Color fundus photograph, 2212x1659 — 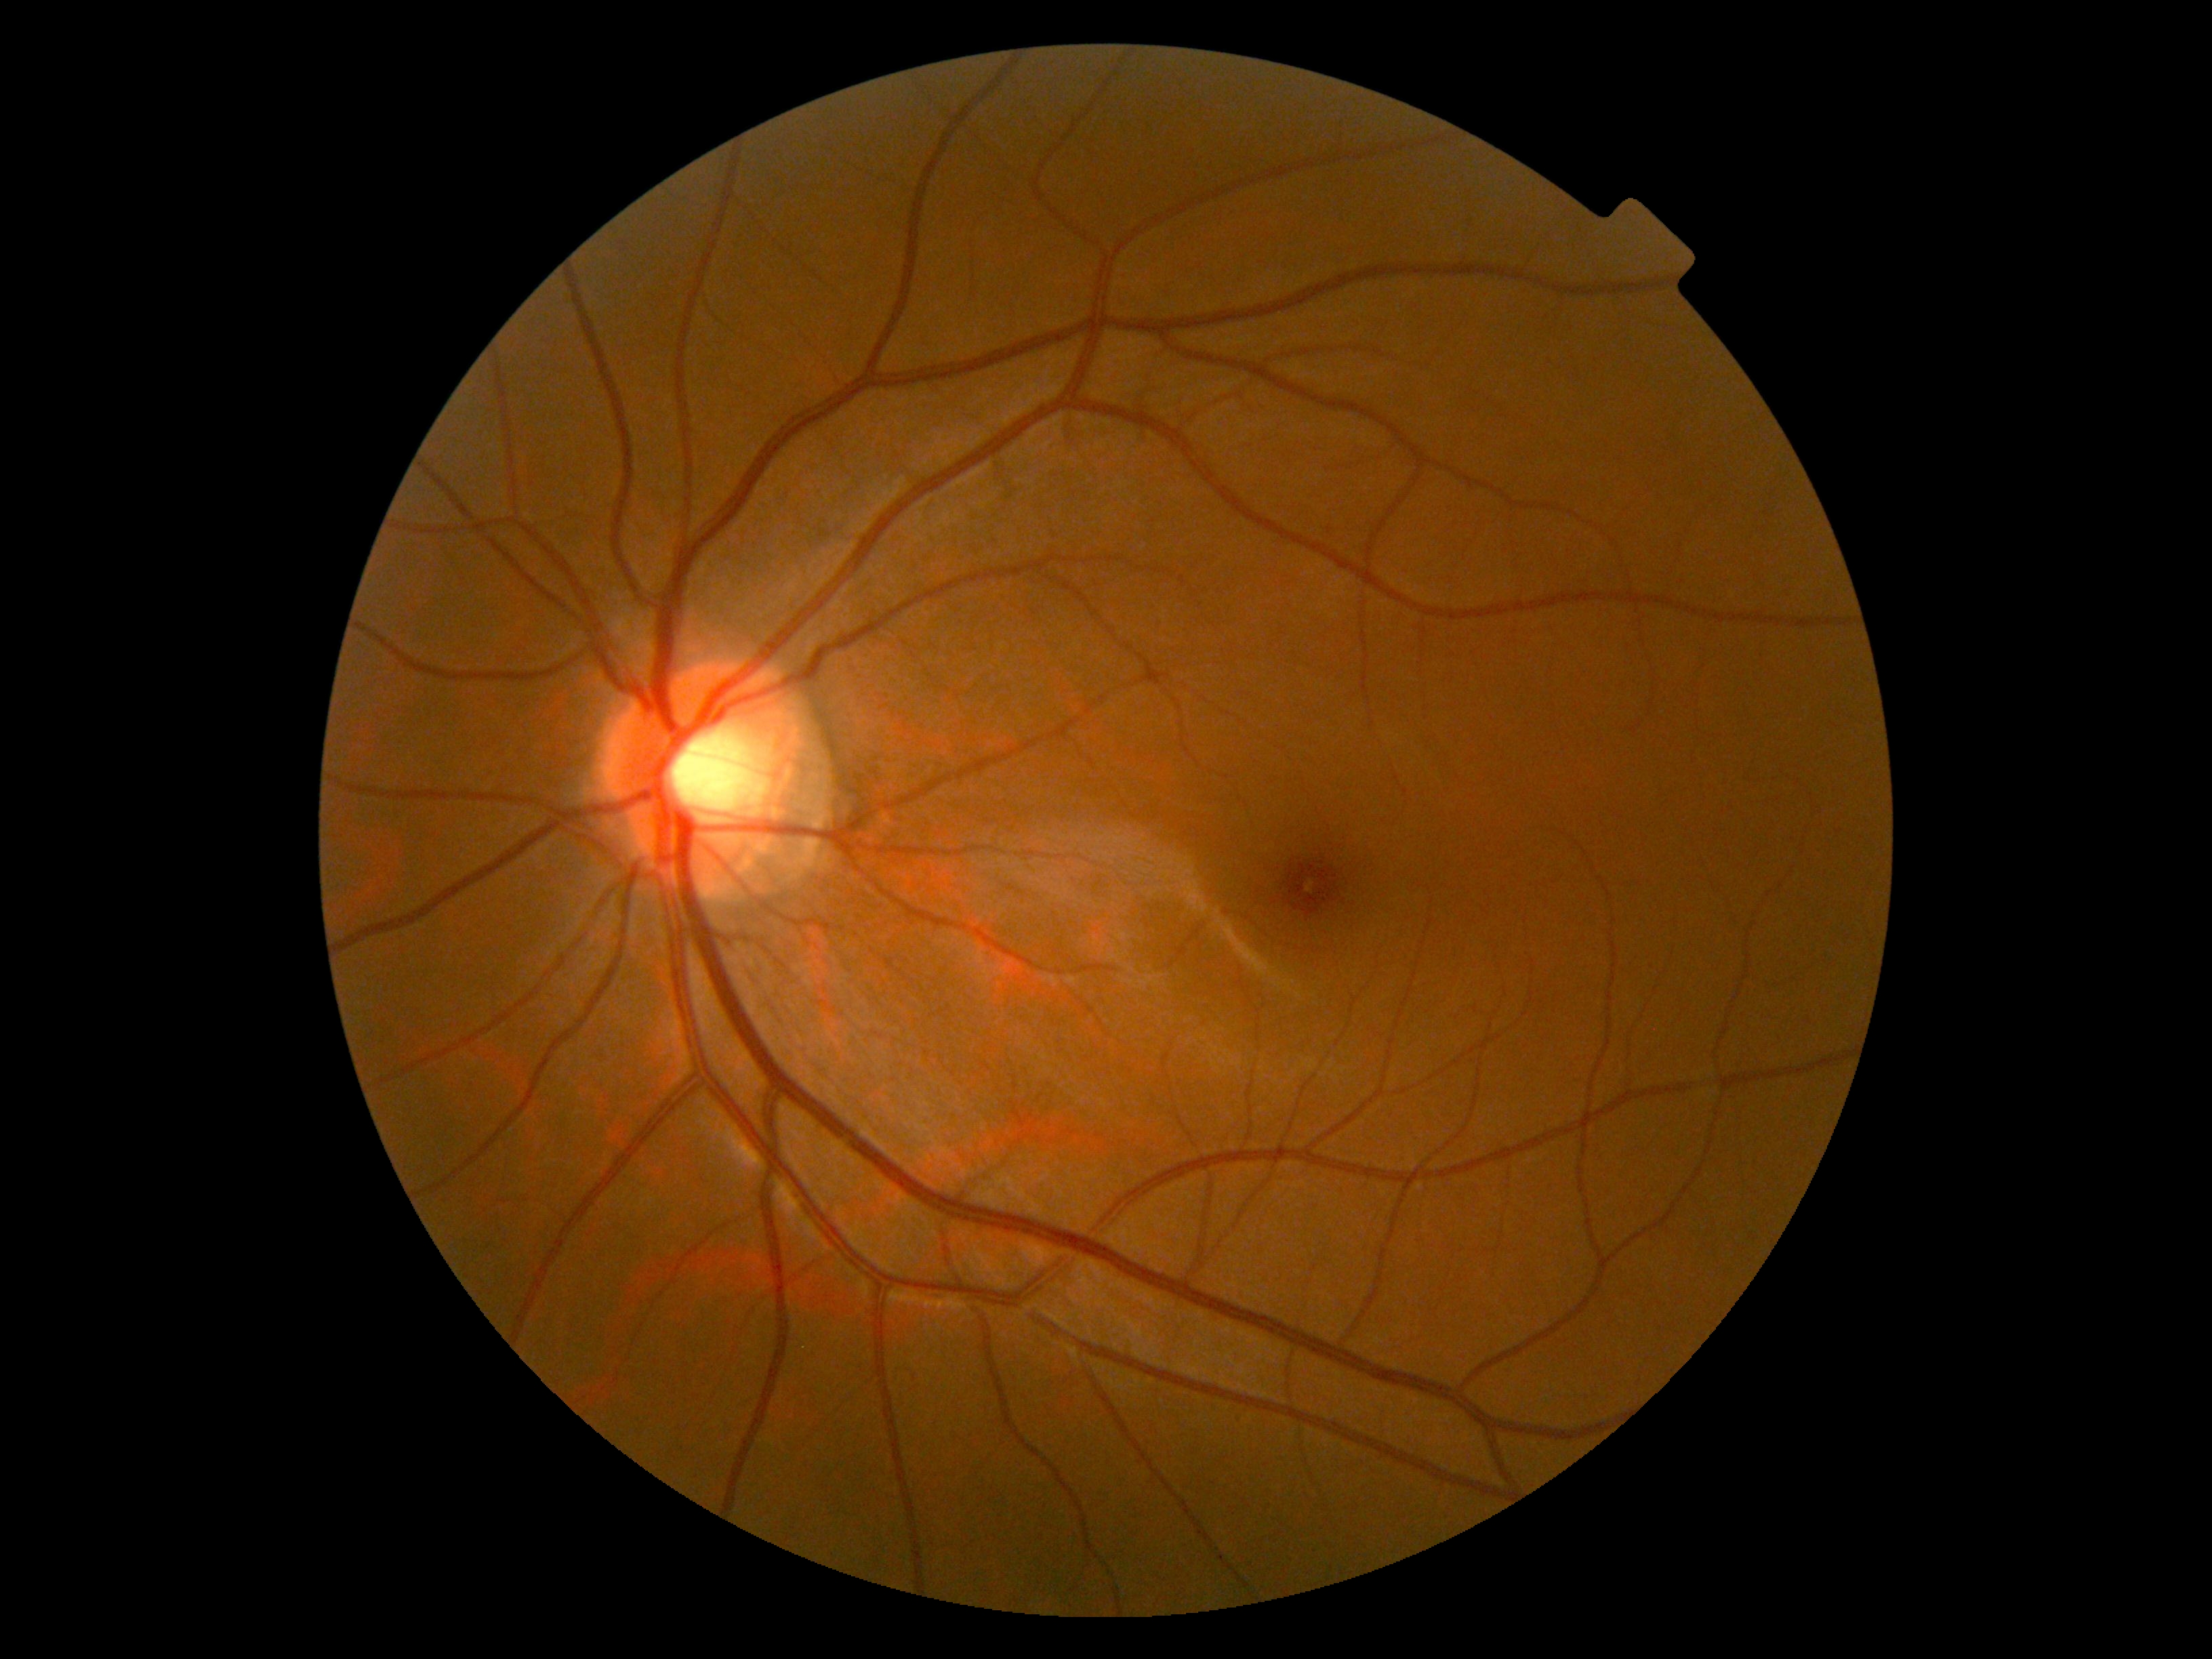 Annotations:
- DR severity — 0/4